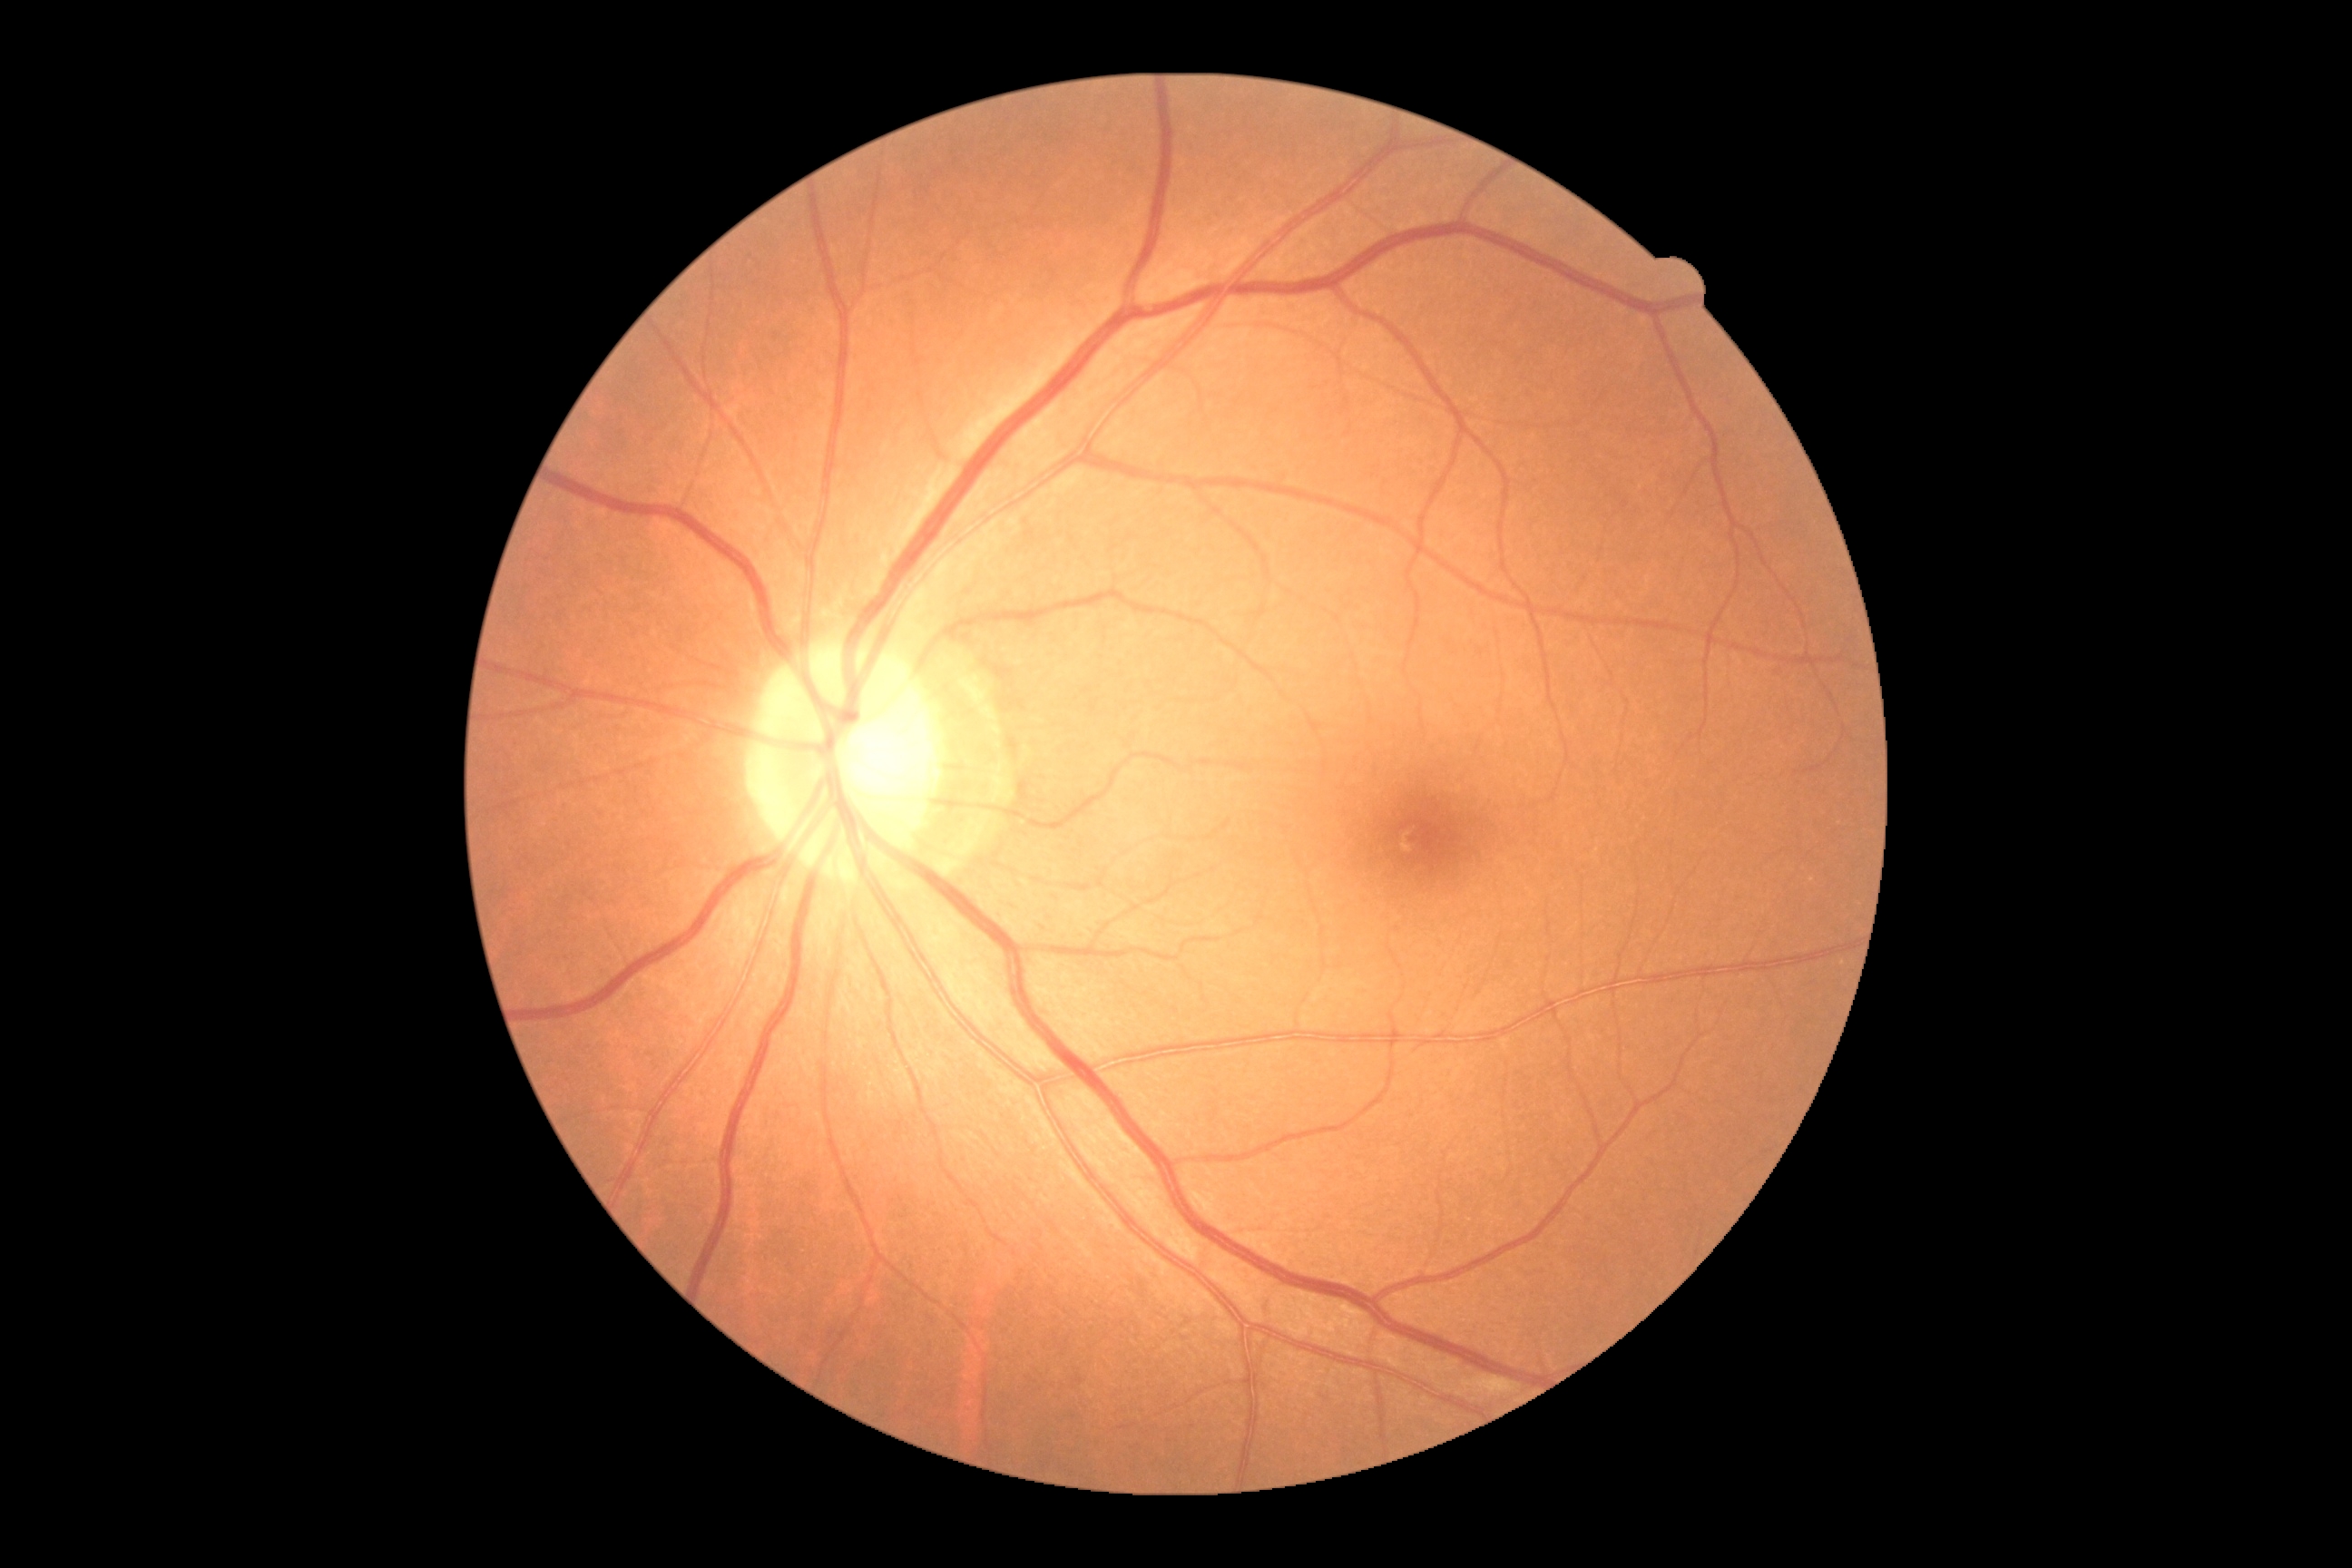 Retinopathy: 0/4.